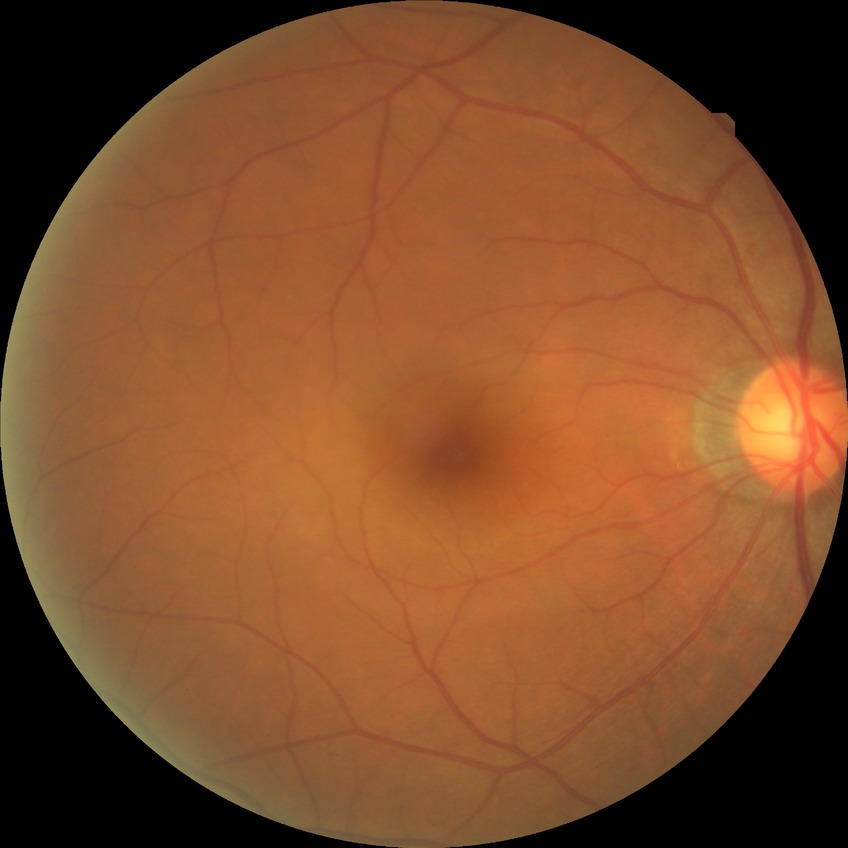
{
  "davis_grade": "no diabetic retinopathy (NDR)"
}